FOV: 45 degrees: 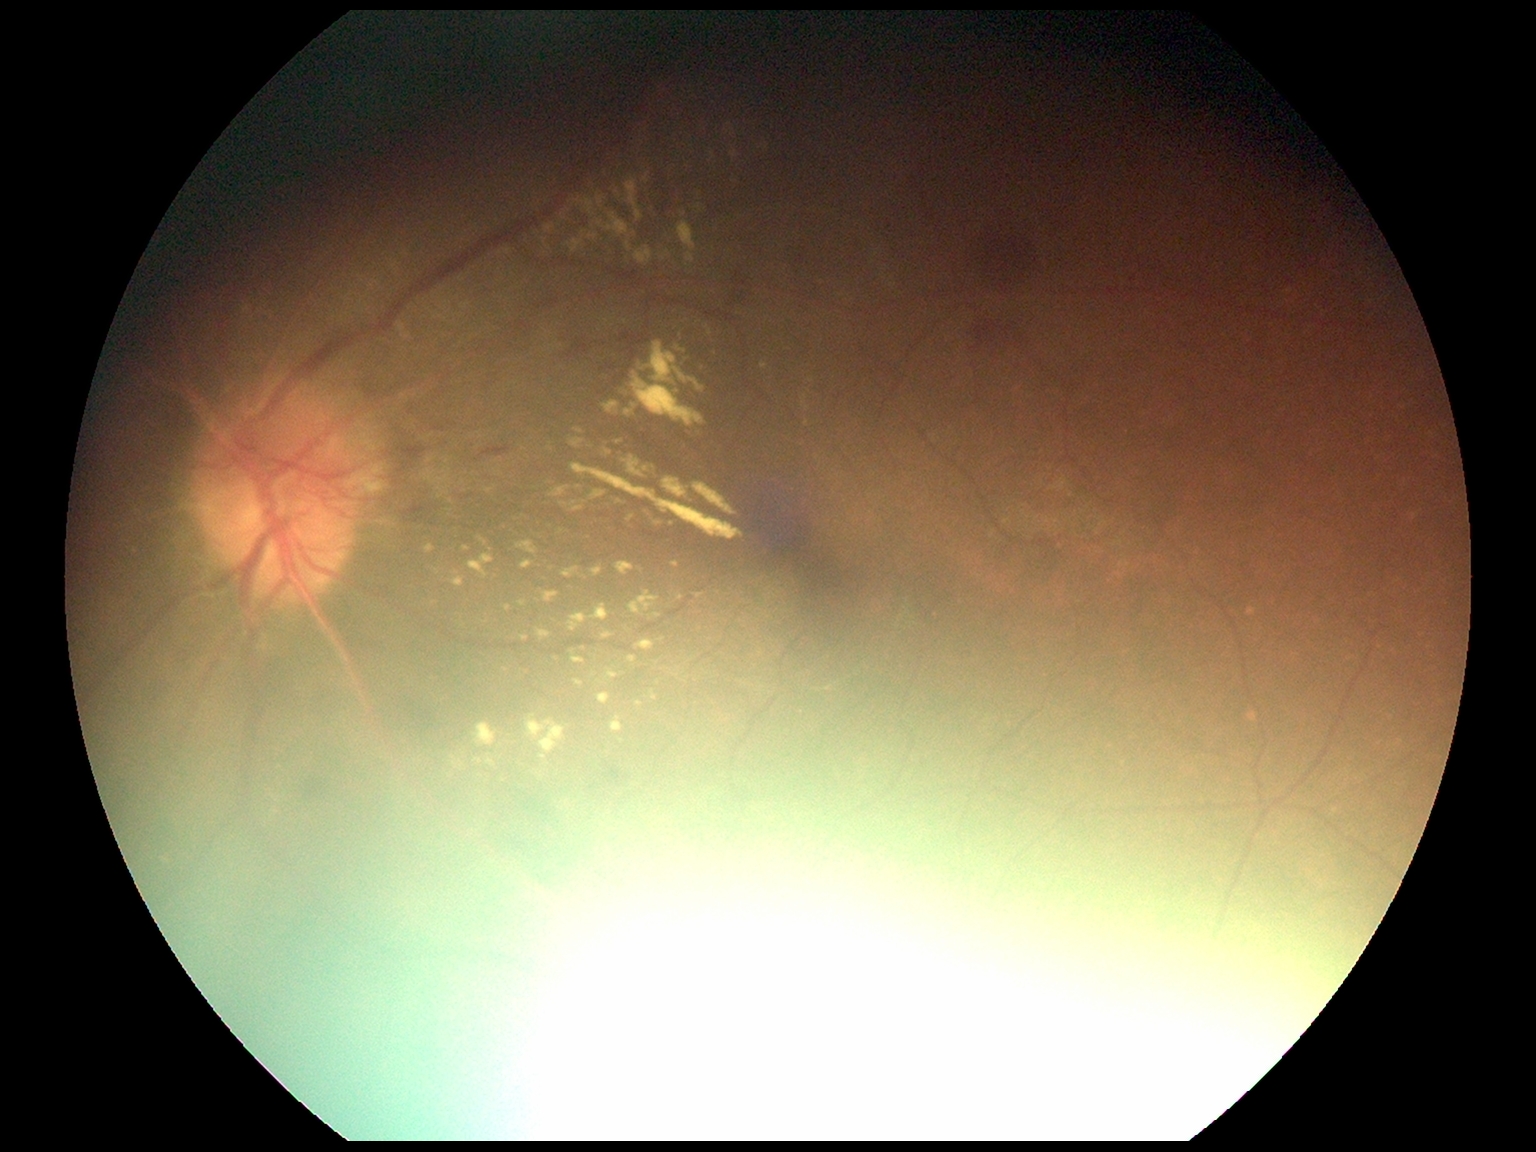 Findings:
• DR stage — grade 2 (moderate NPDR)
• DR class — non-proliferative diabetic retinopathy